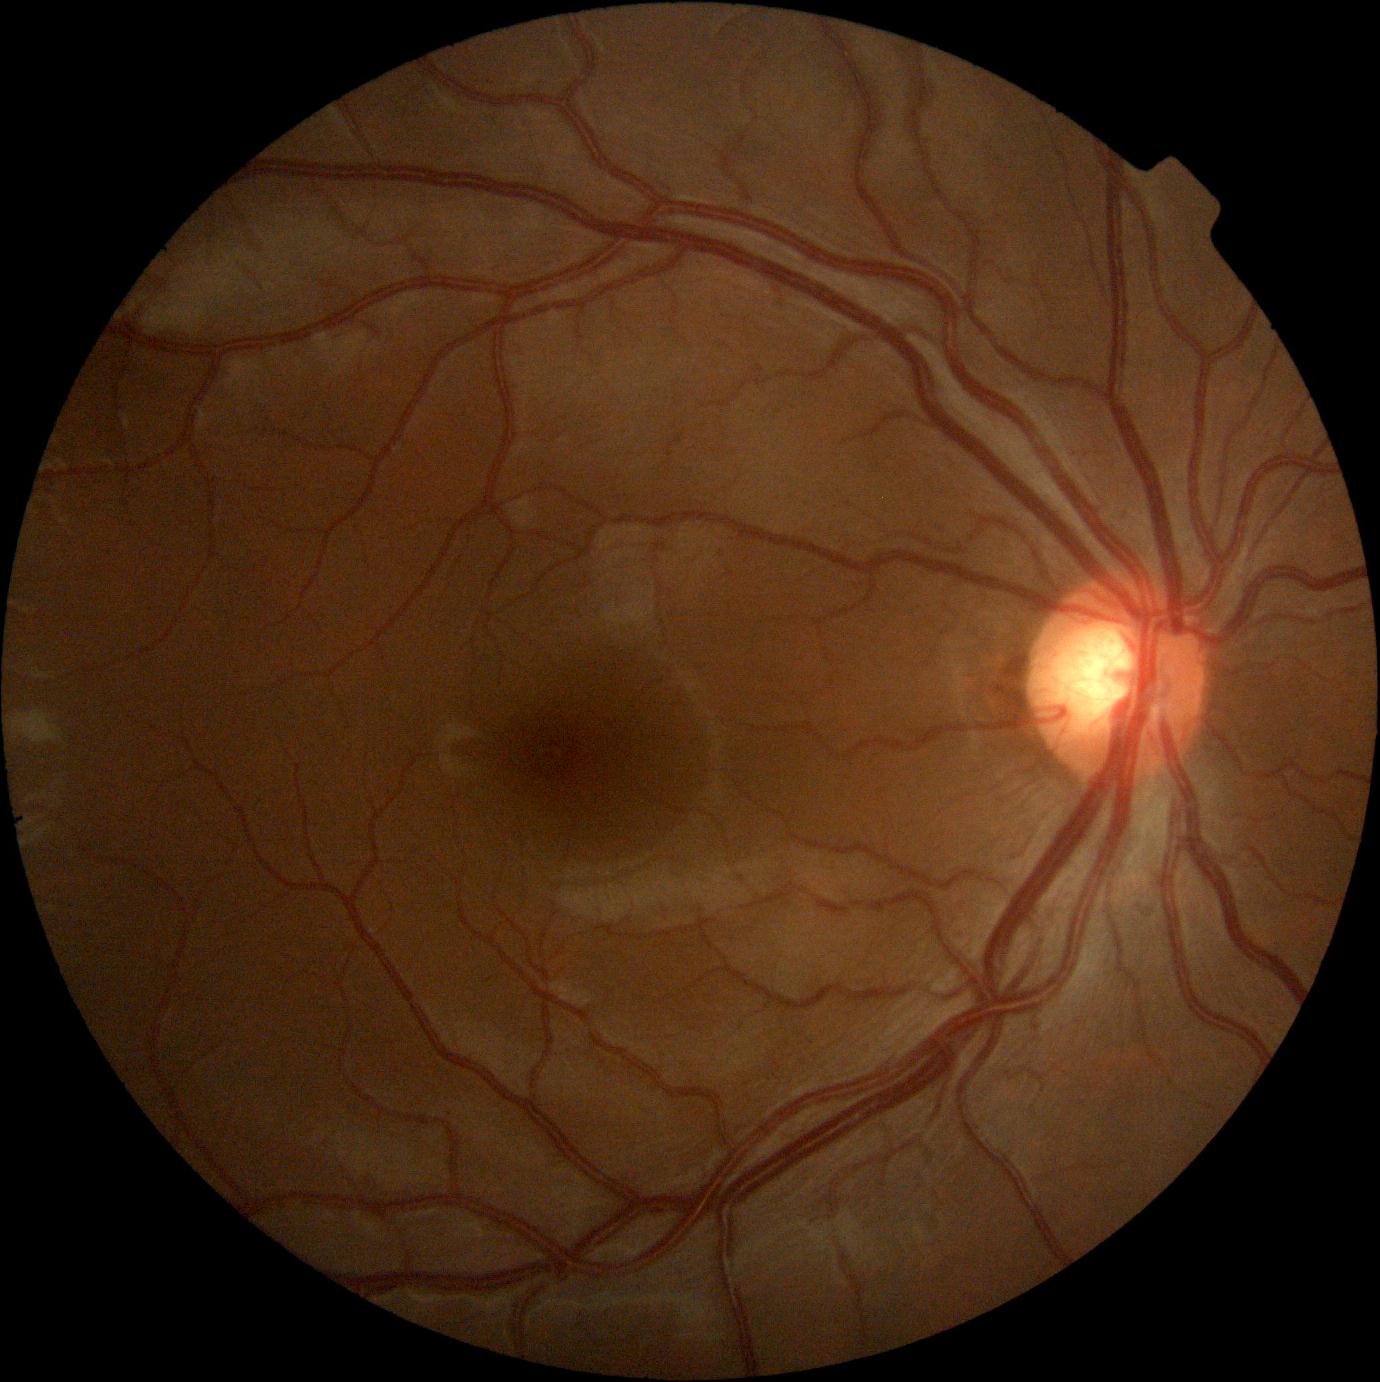
Annotations:
* DR impression — negative for DR
* DR stage — 0